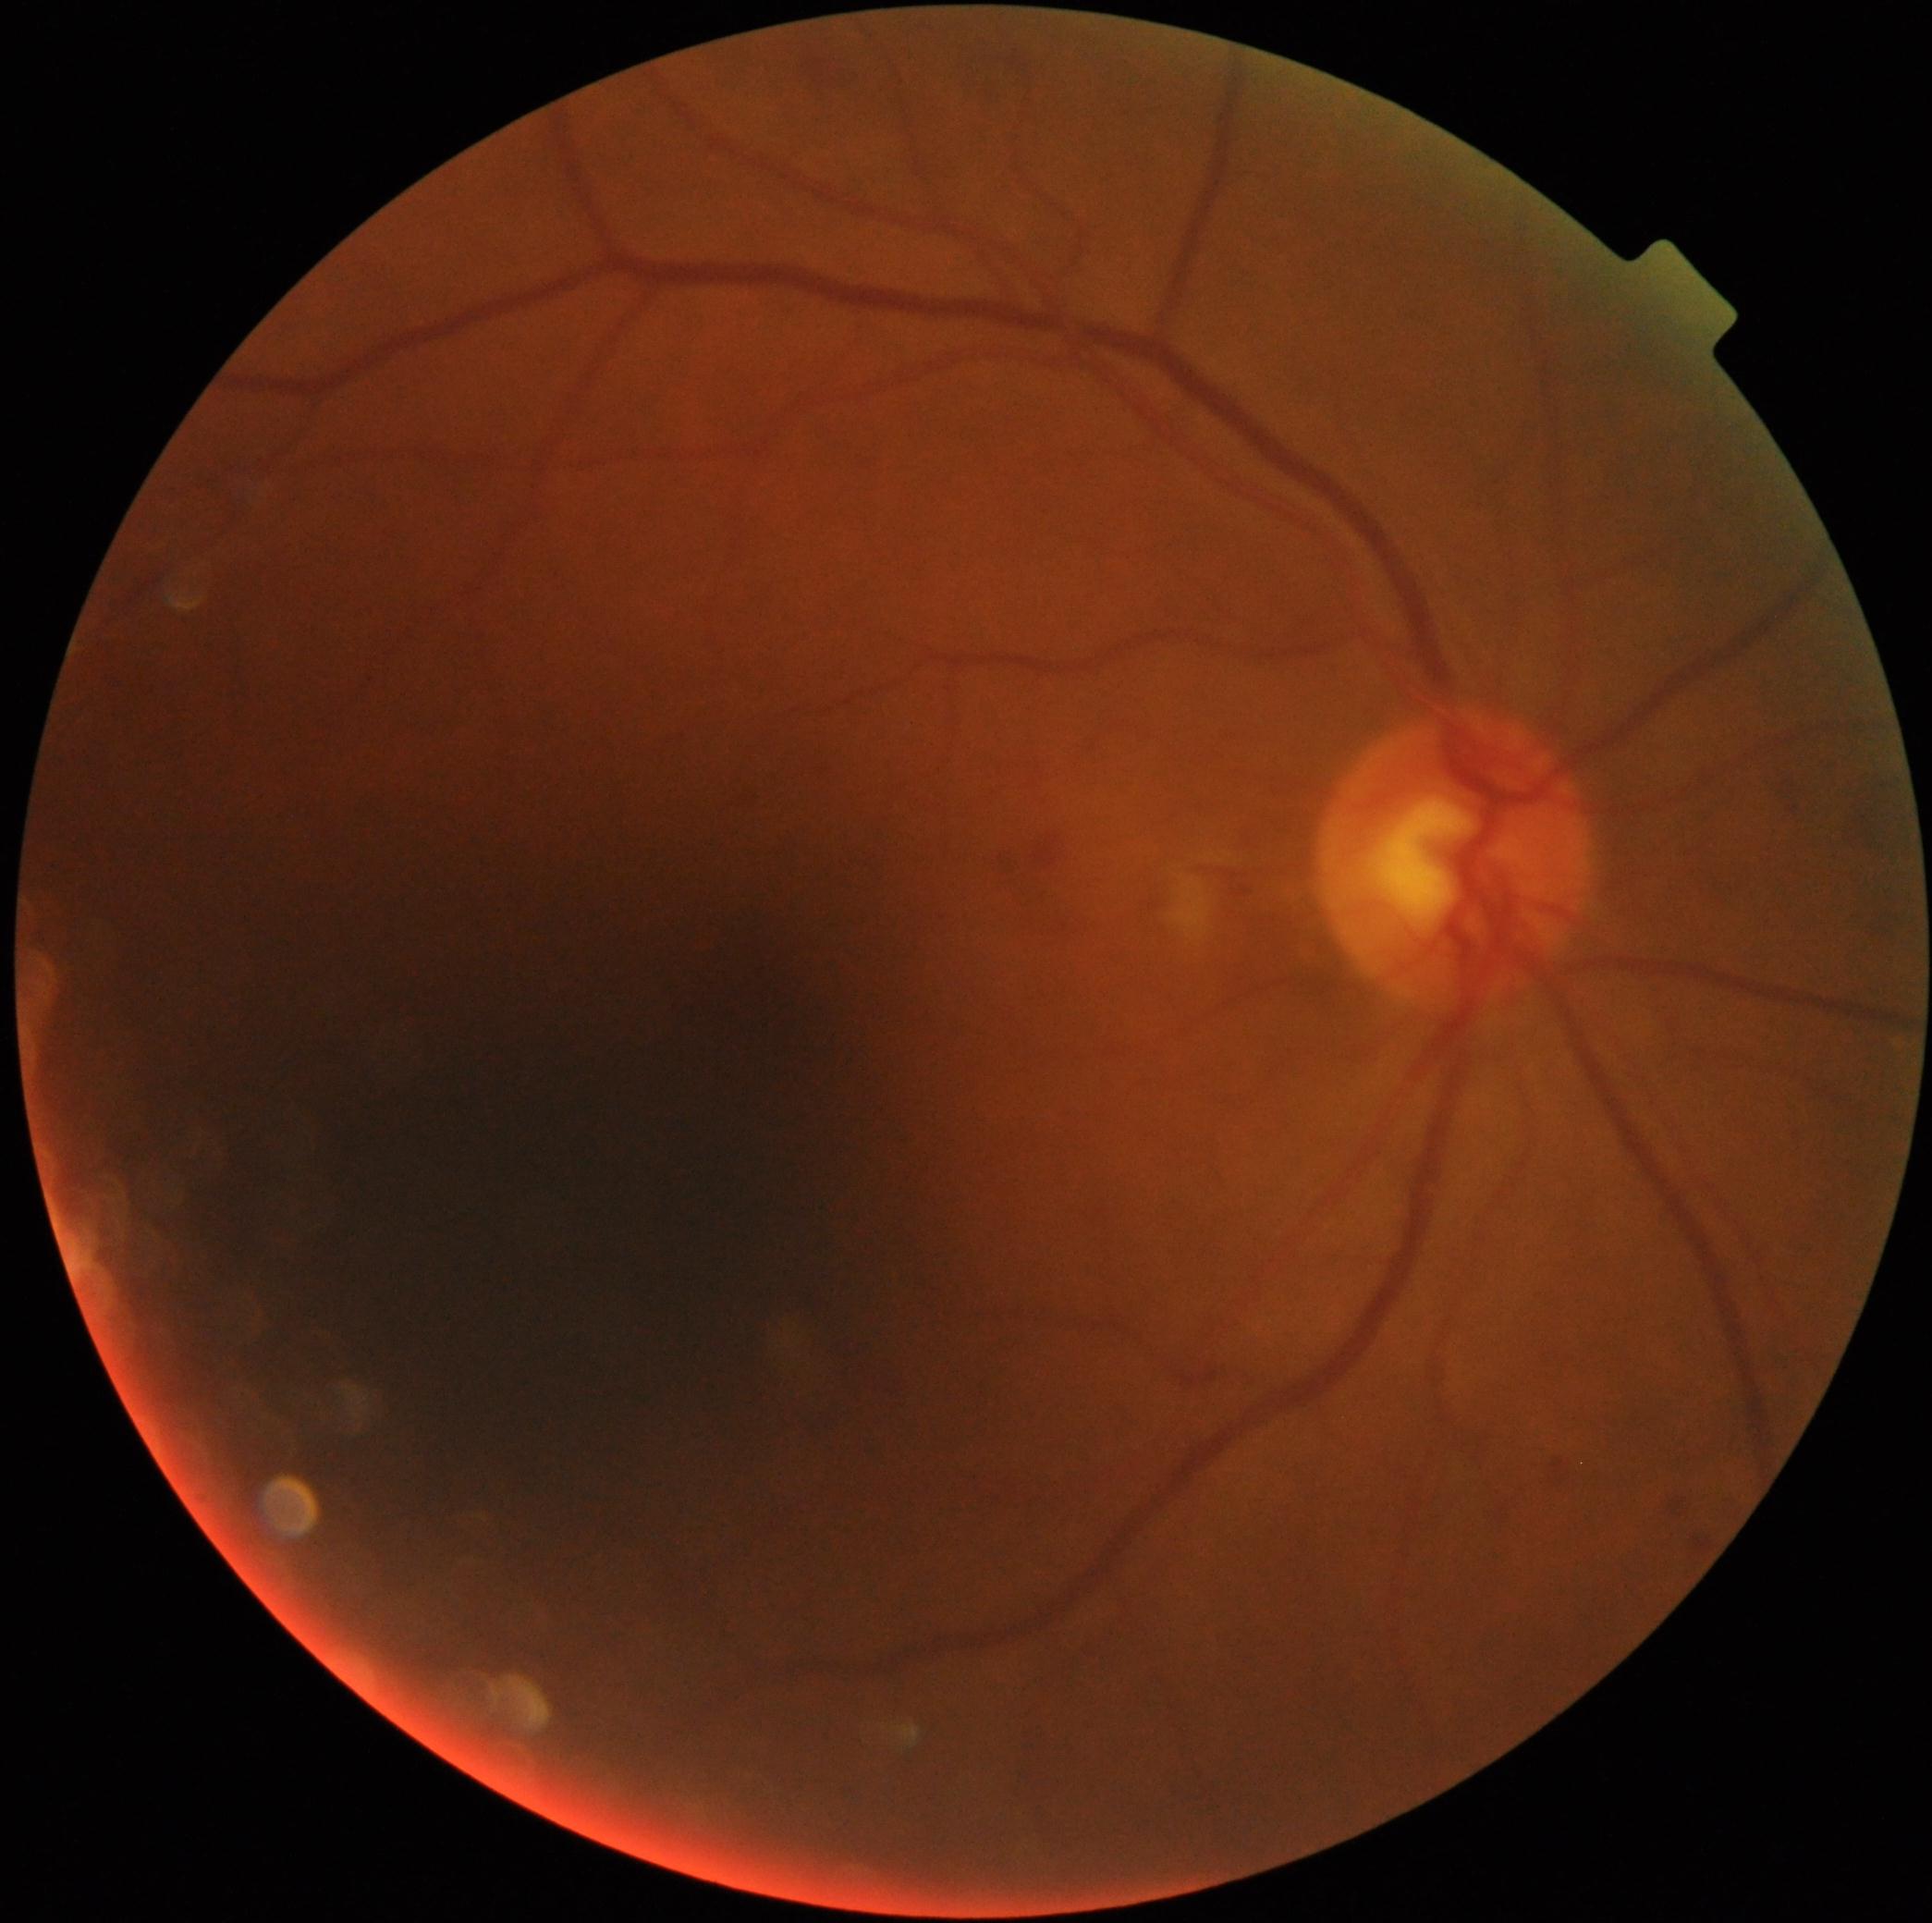 The retinopathy is classified as non-proliferative diabetic retinopathy. DR stage: 2/4.